Acquired with a NIDEK AFC-230, modified Davis classification: 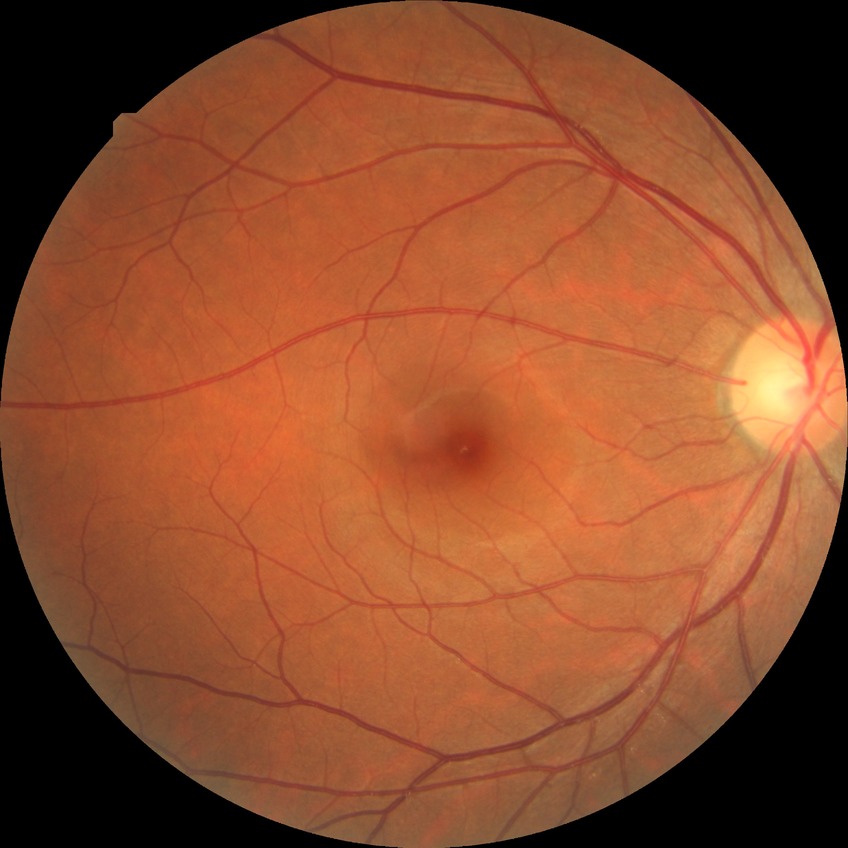 diabetic retinopathy (DR): no diabetic retinopathy (NDR).